Pediatric wide-field fundus photograph; acquired on the Clarity RetCam 3
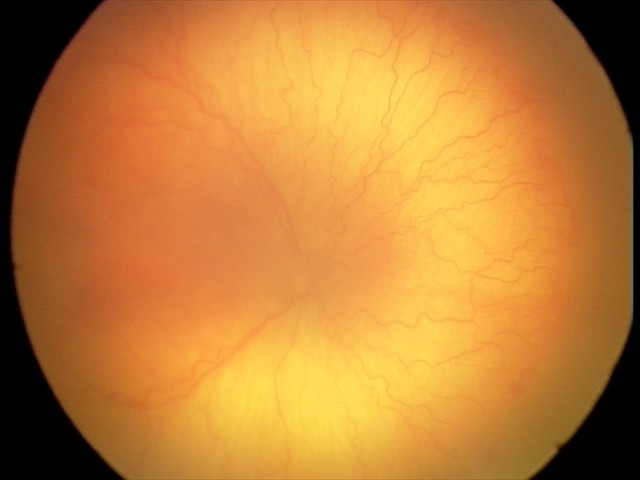

Diagnosis from this screening exam: aggressive ROP (A-ROP).